Wide-field fundus photograph of an infant: 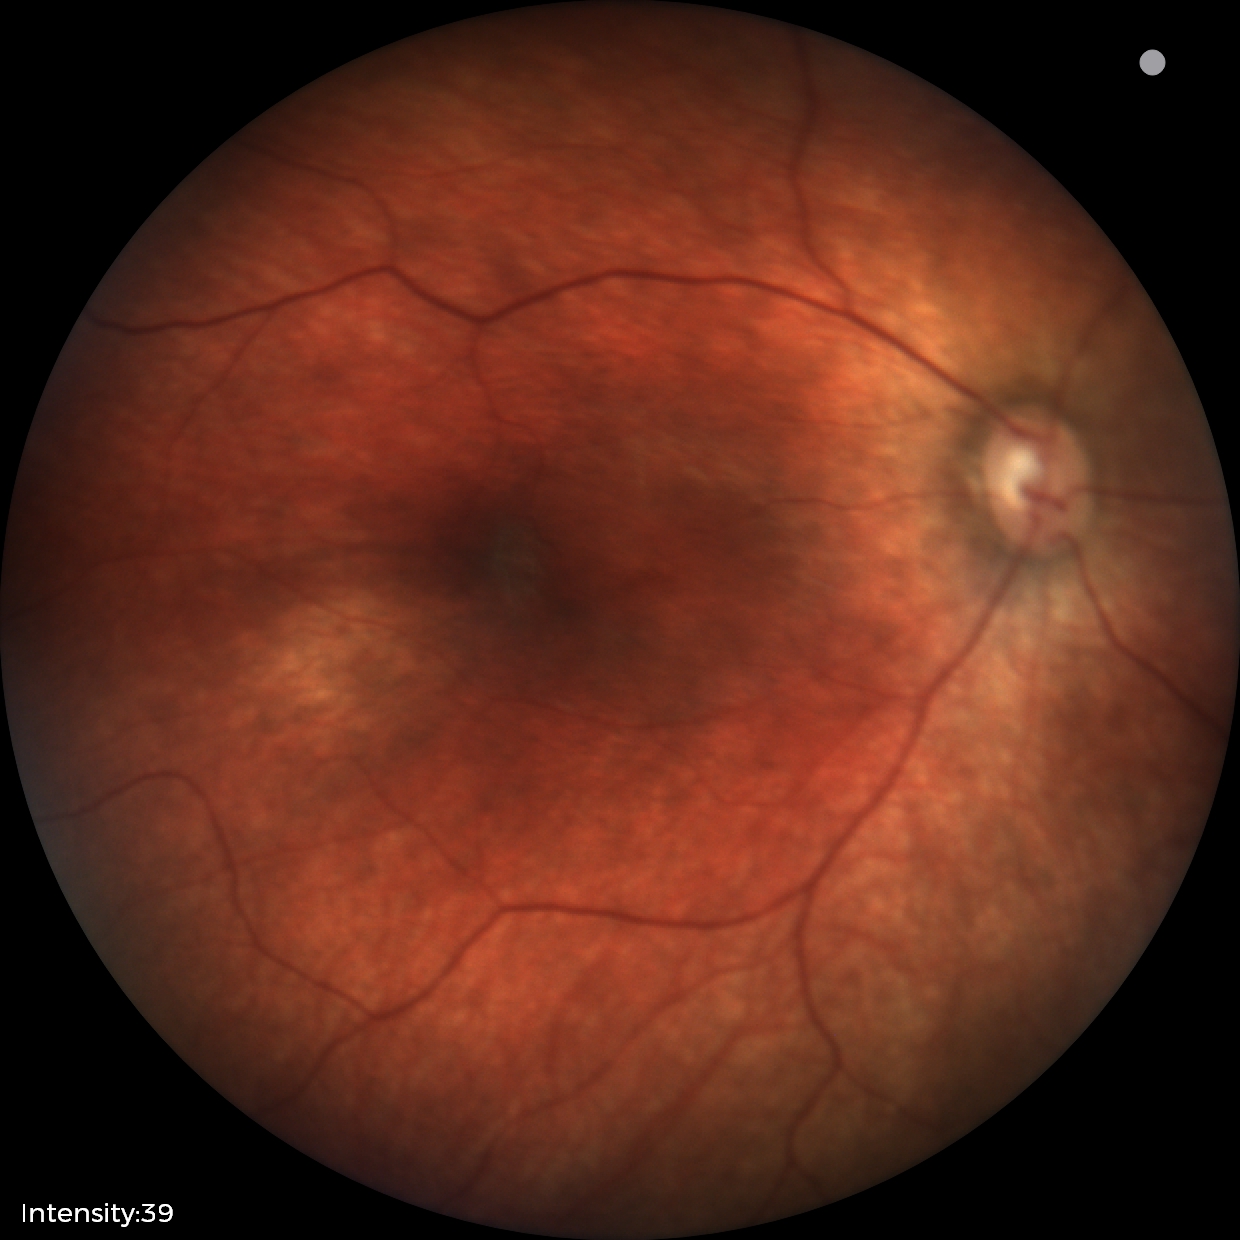

No retinal pathology identified on screening.